Retinal fundus photograph
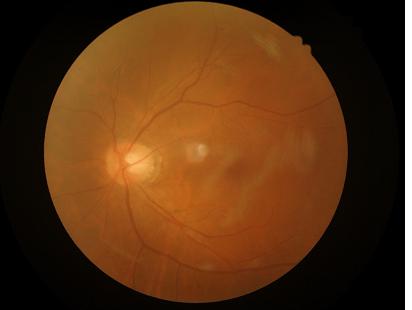

Image quality: sharpness: noticeable blur in the optic disc, vessels, or background; overall: poor and difficult to use diagnostically; illumination: even and well-balanced.